45° FOV · fundus photo
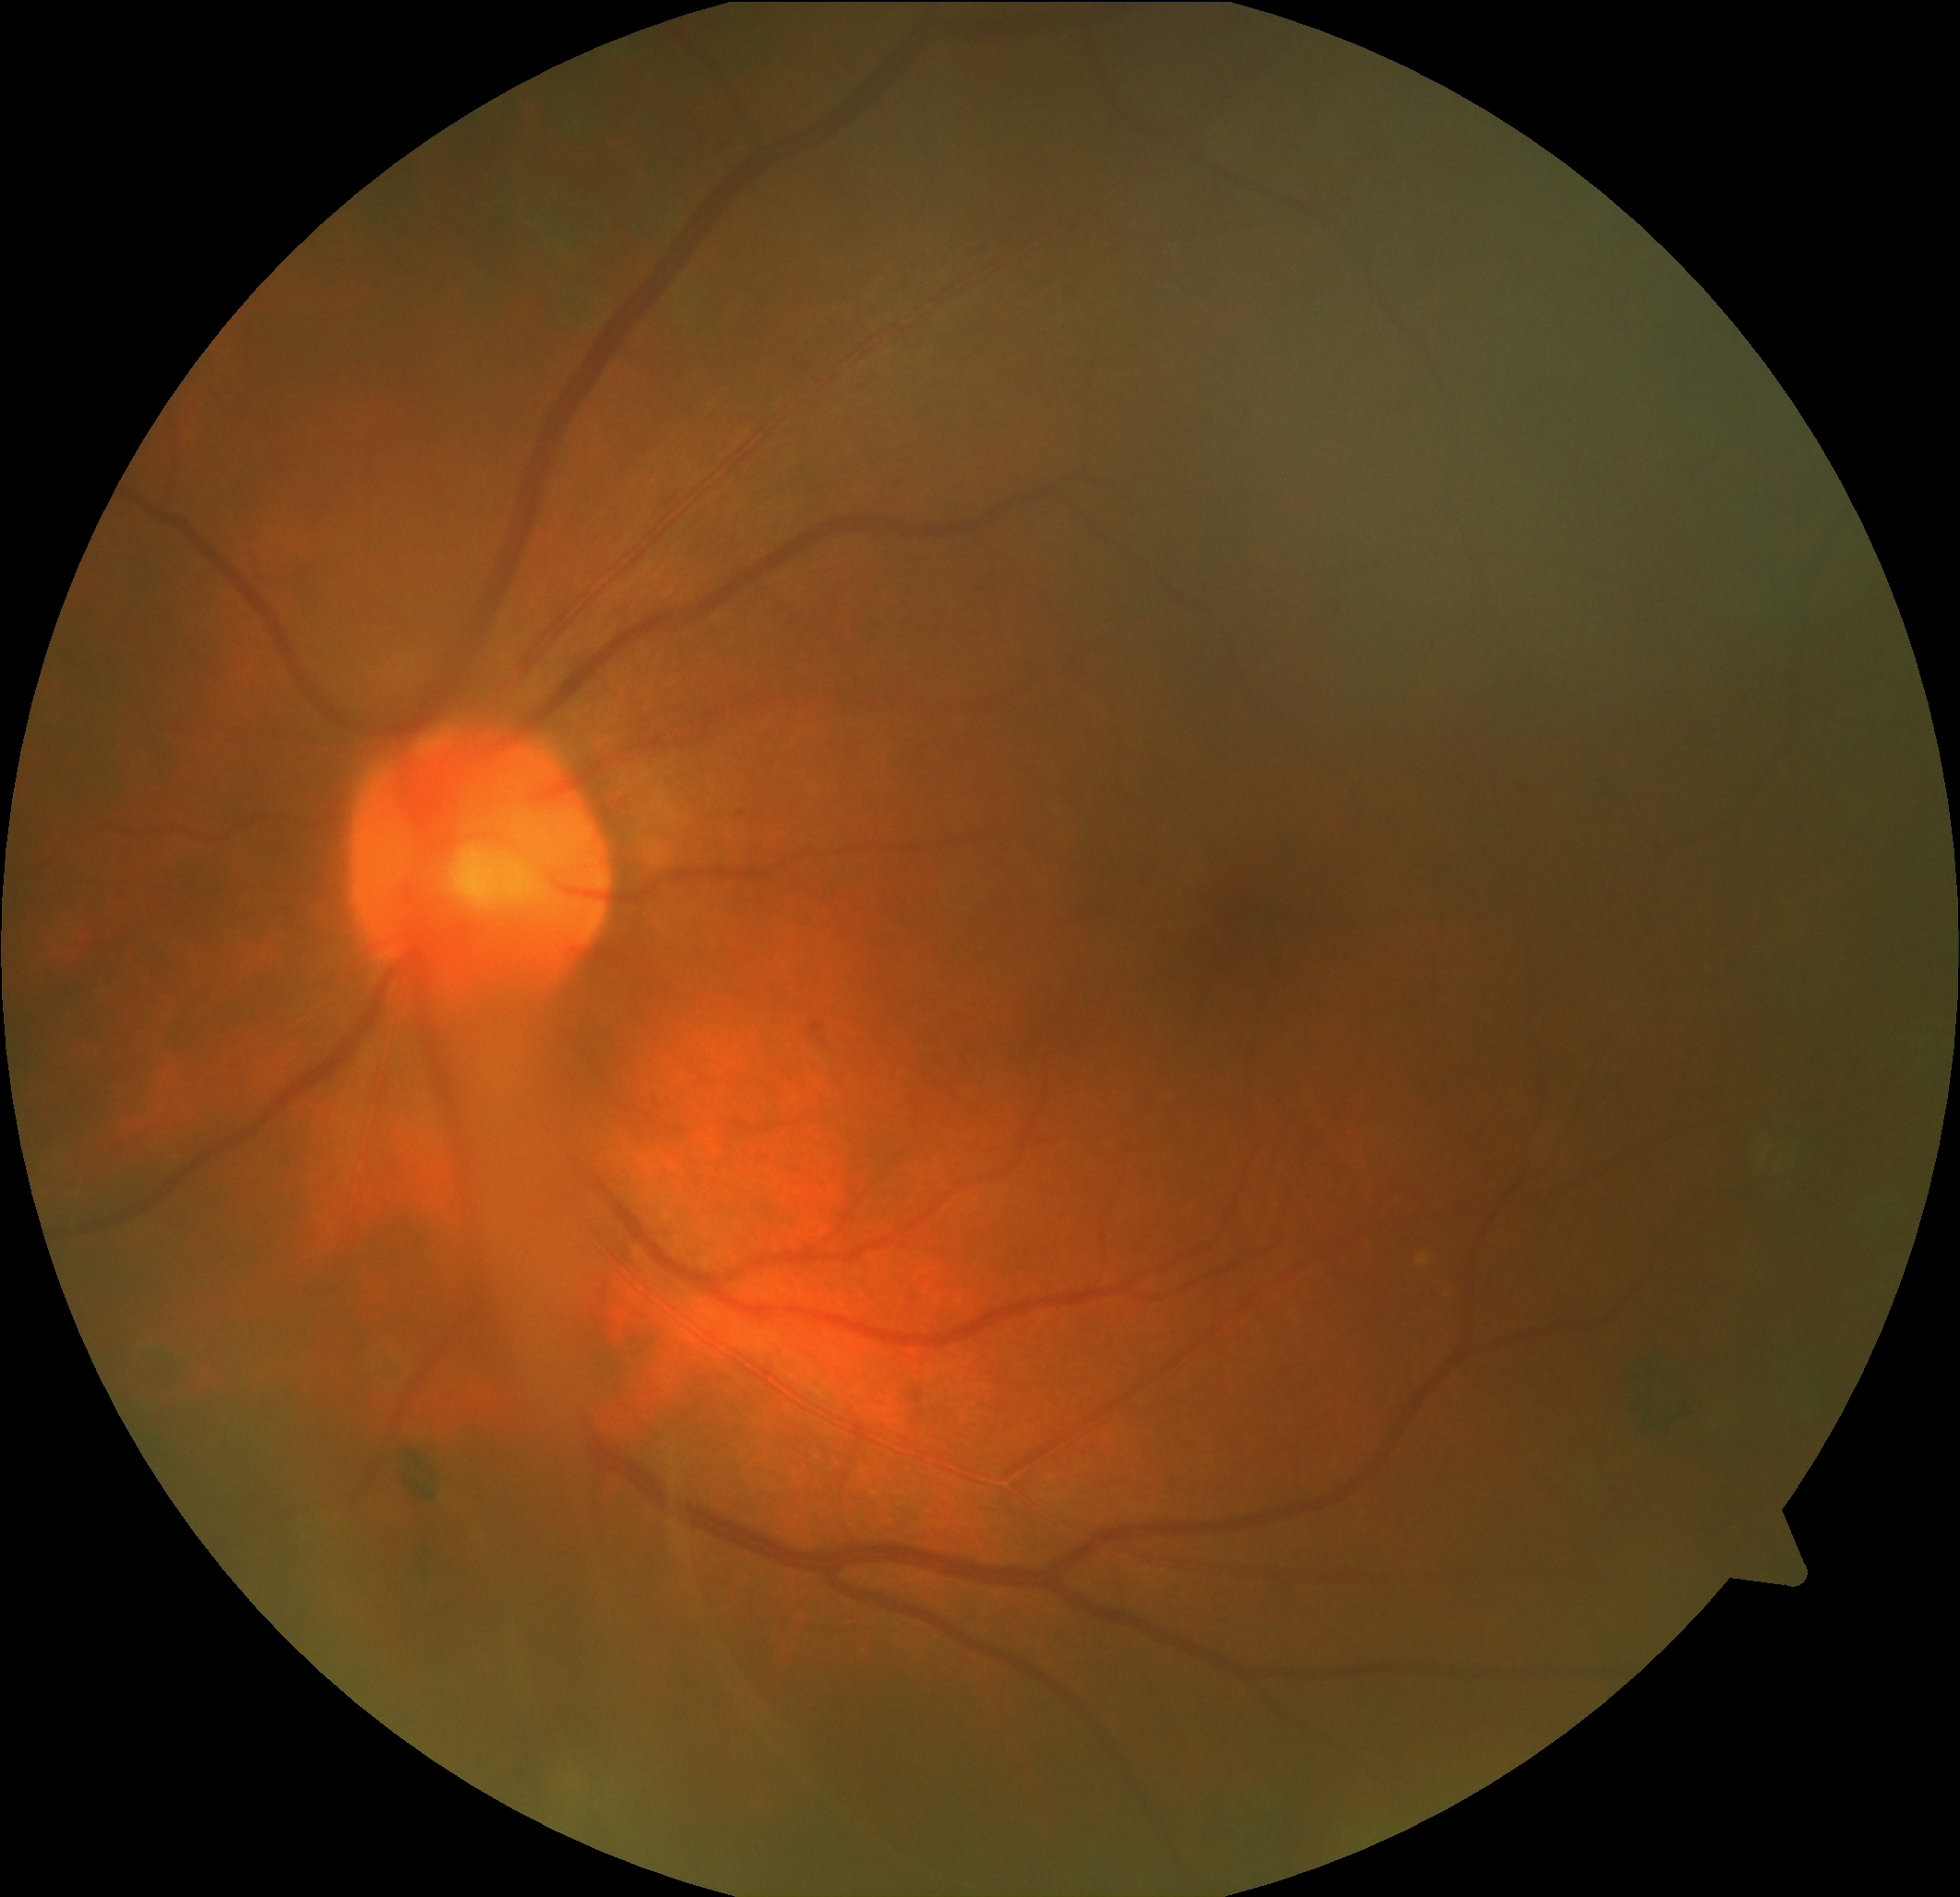 DR stage: mild non-proliferative diabetic retinopathy (grade 1).
Disease class: non-proliferative diabetic retinopathy.